2102x1736:
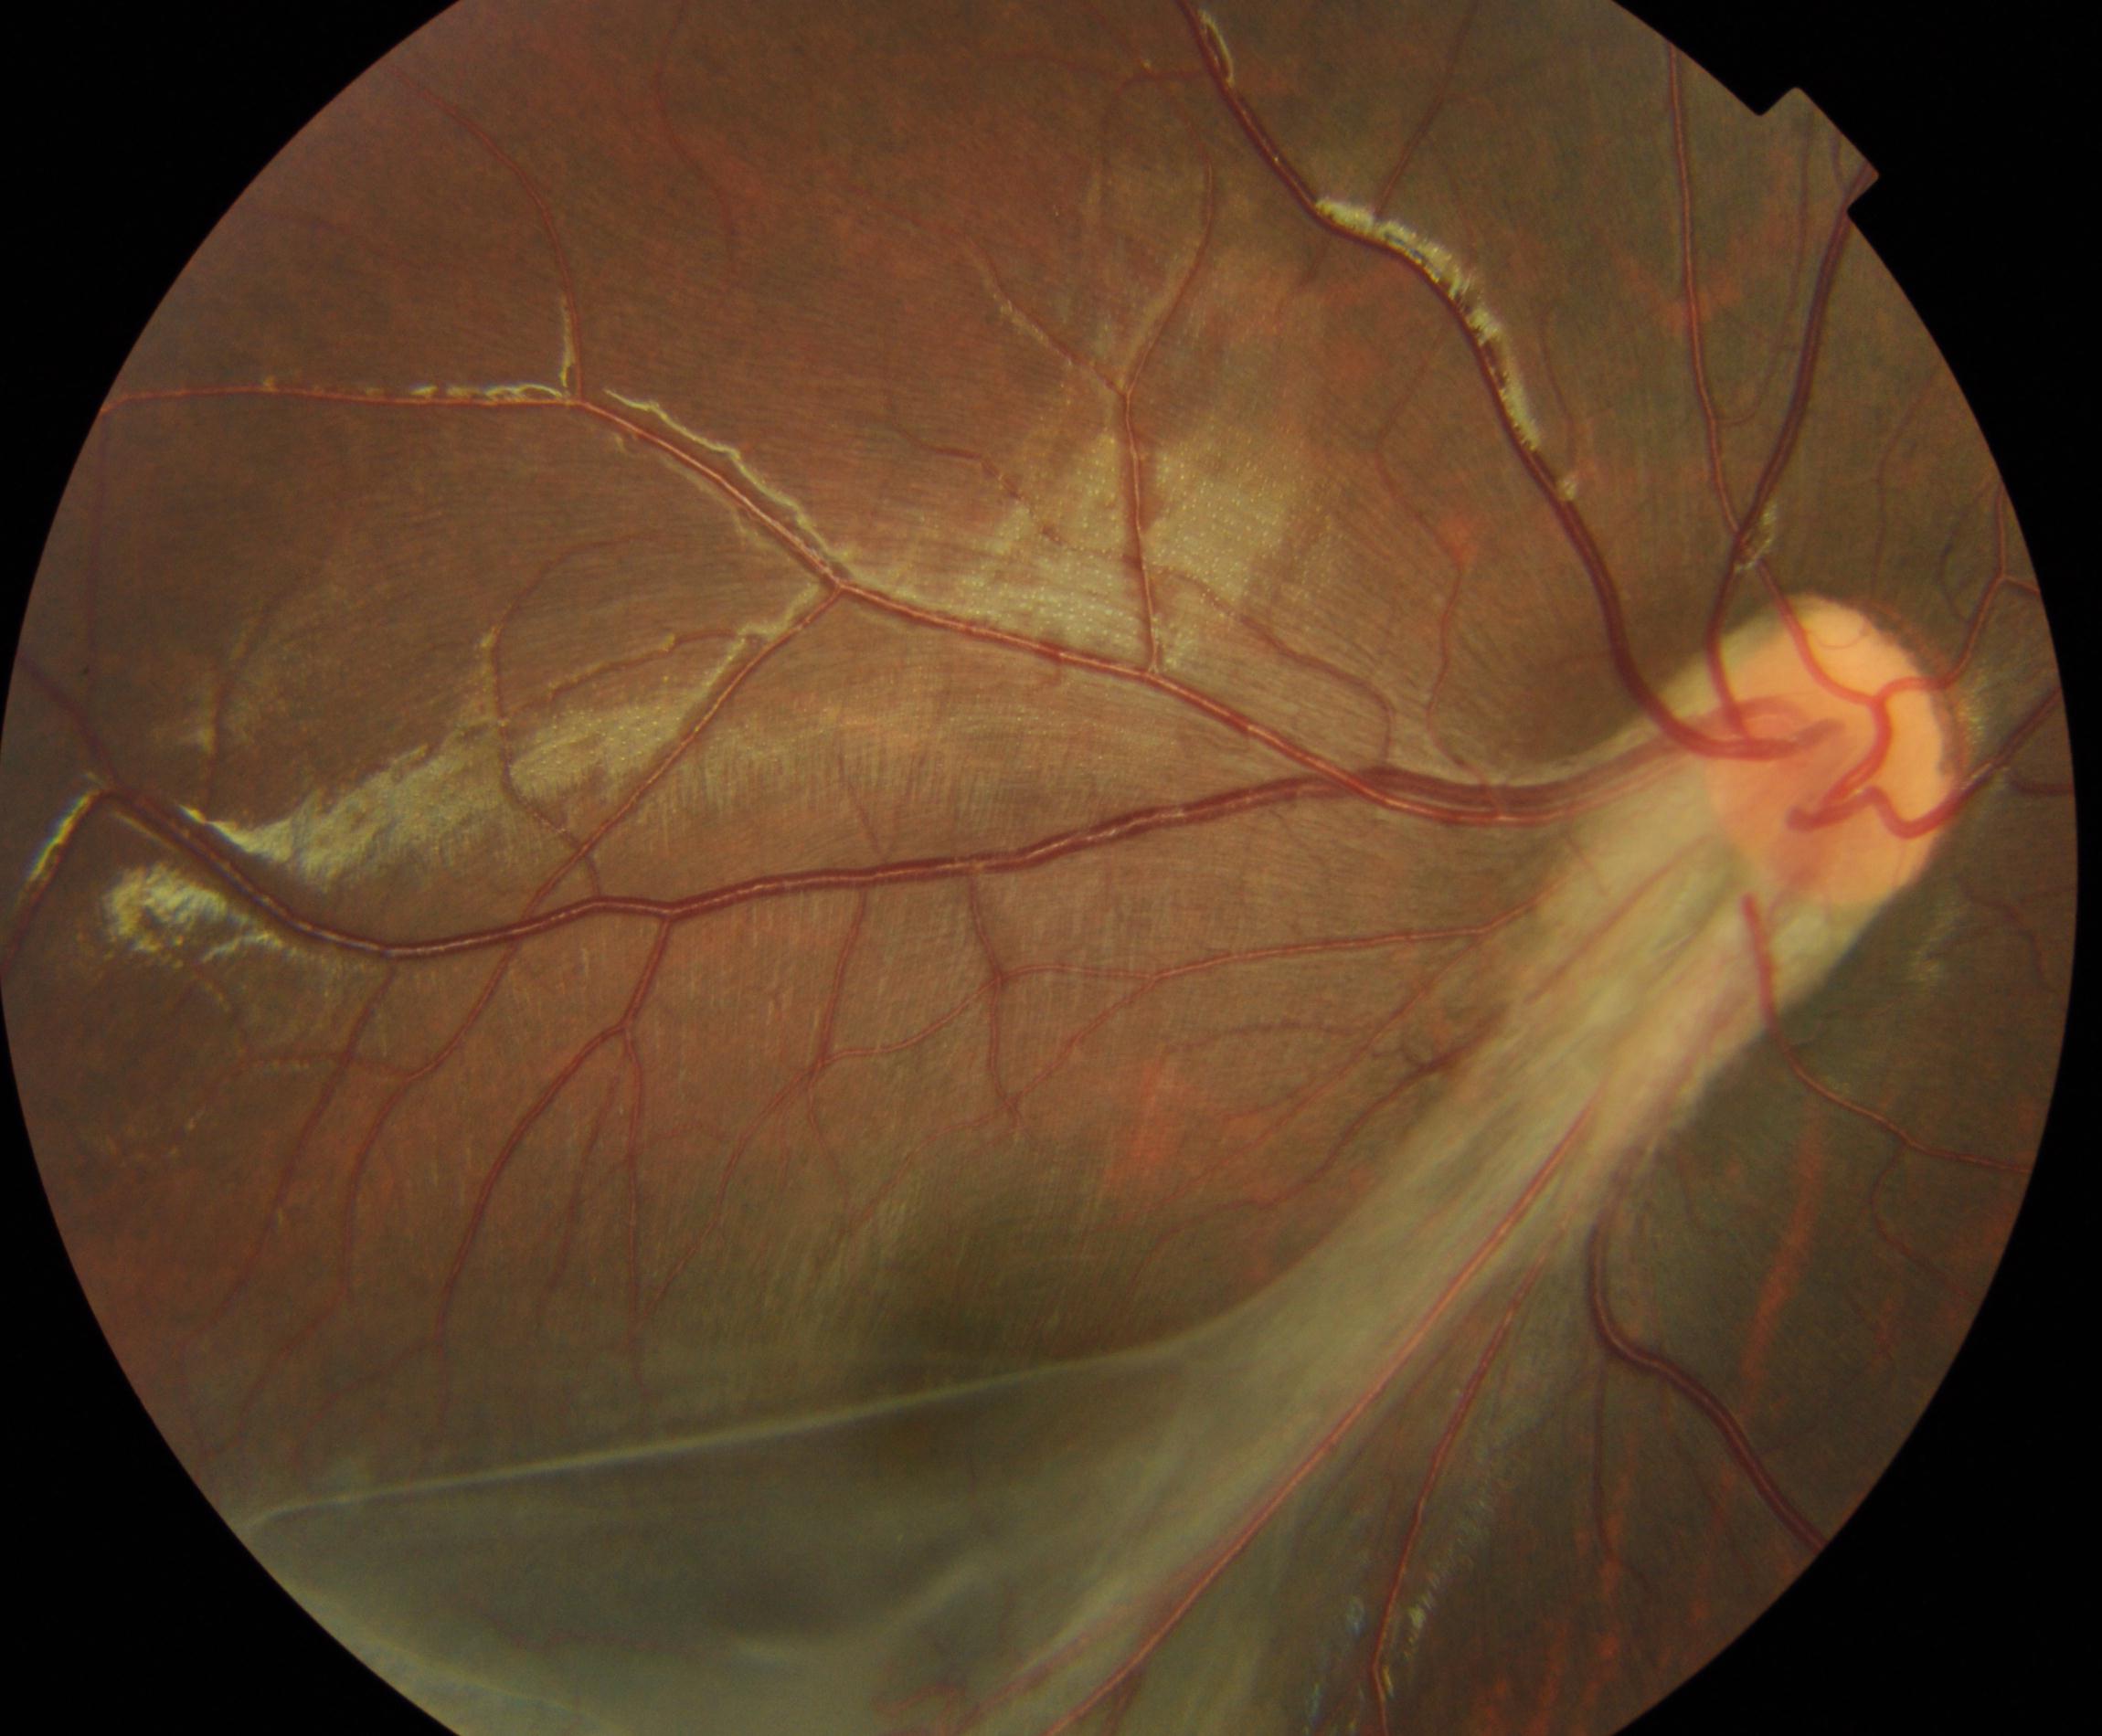
There is evidence of dragged disc.